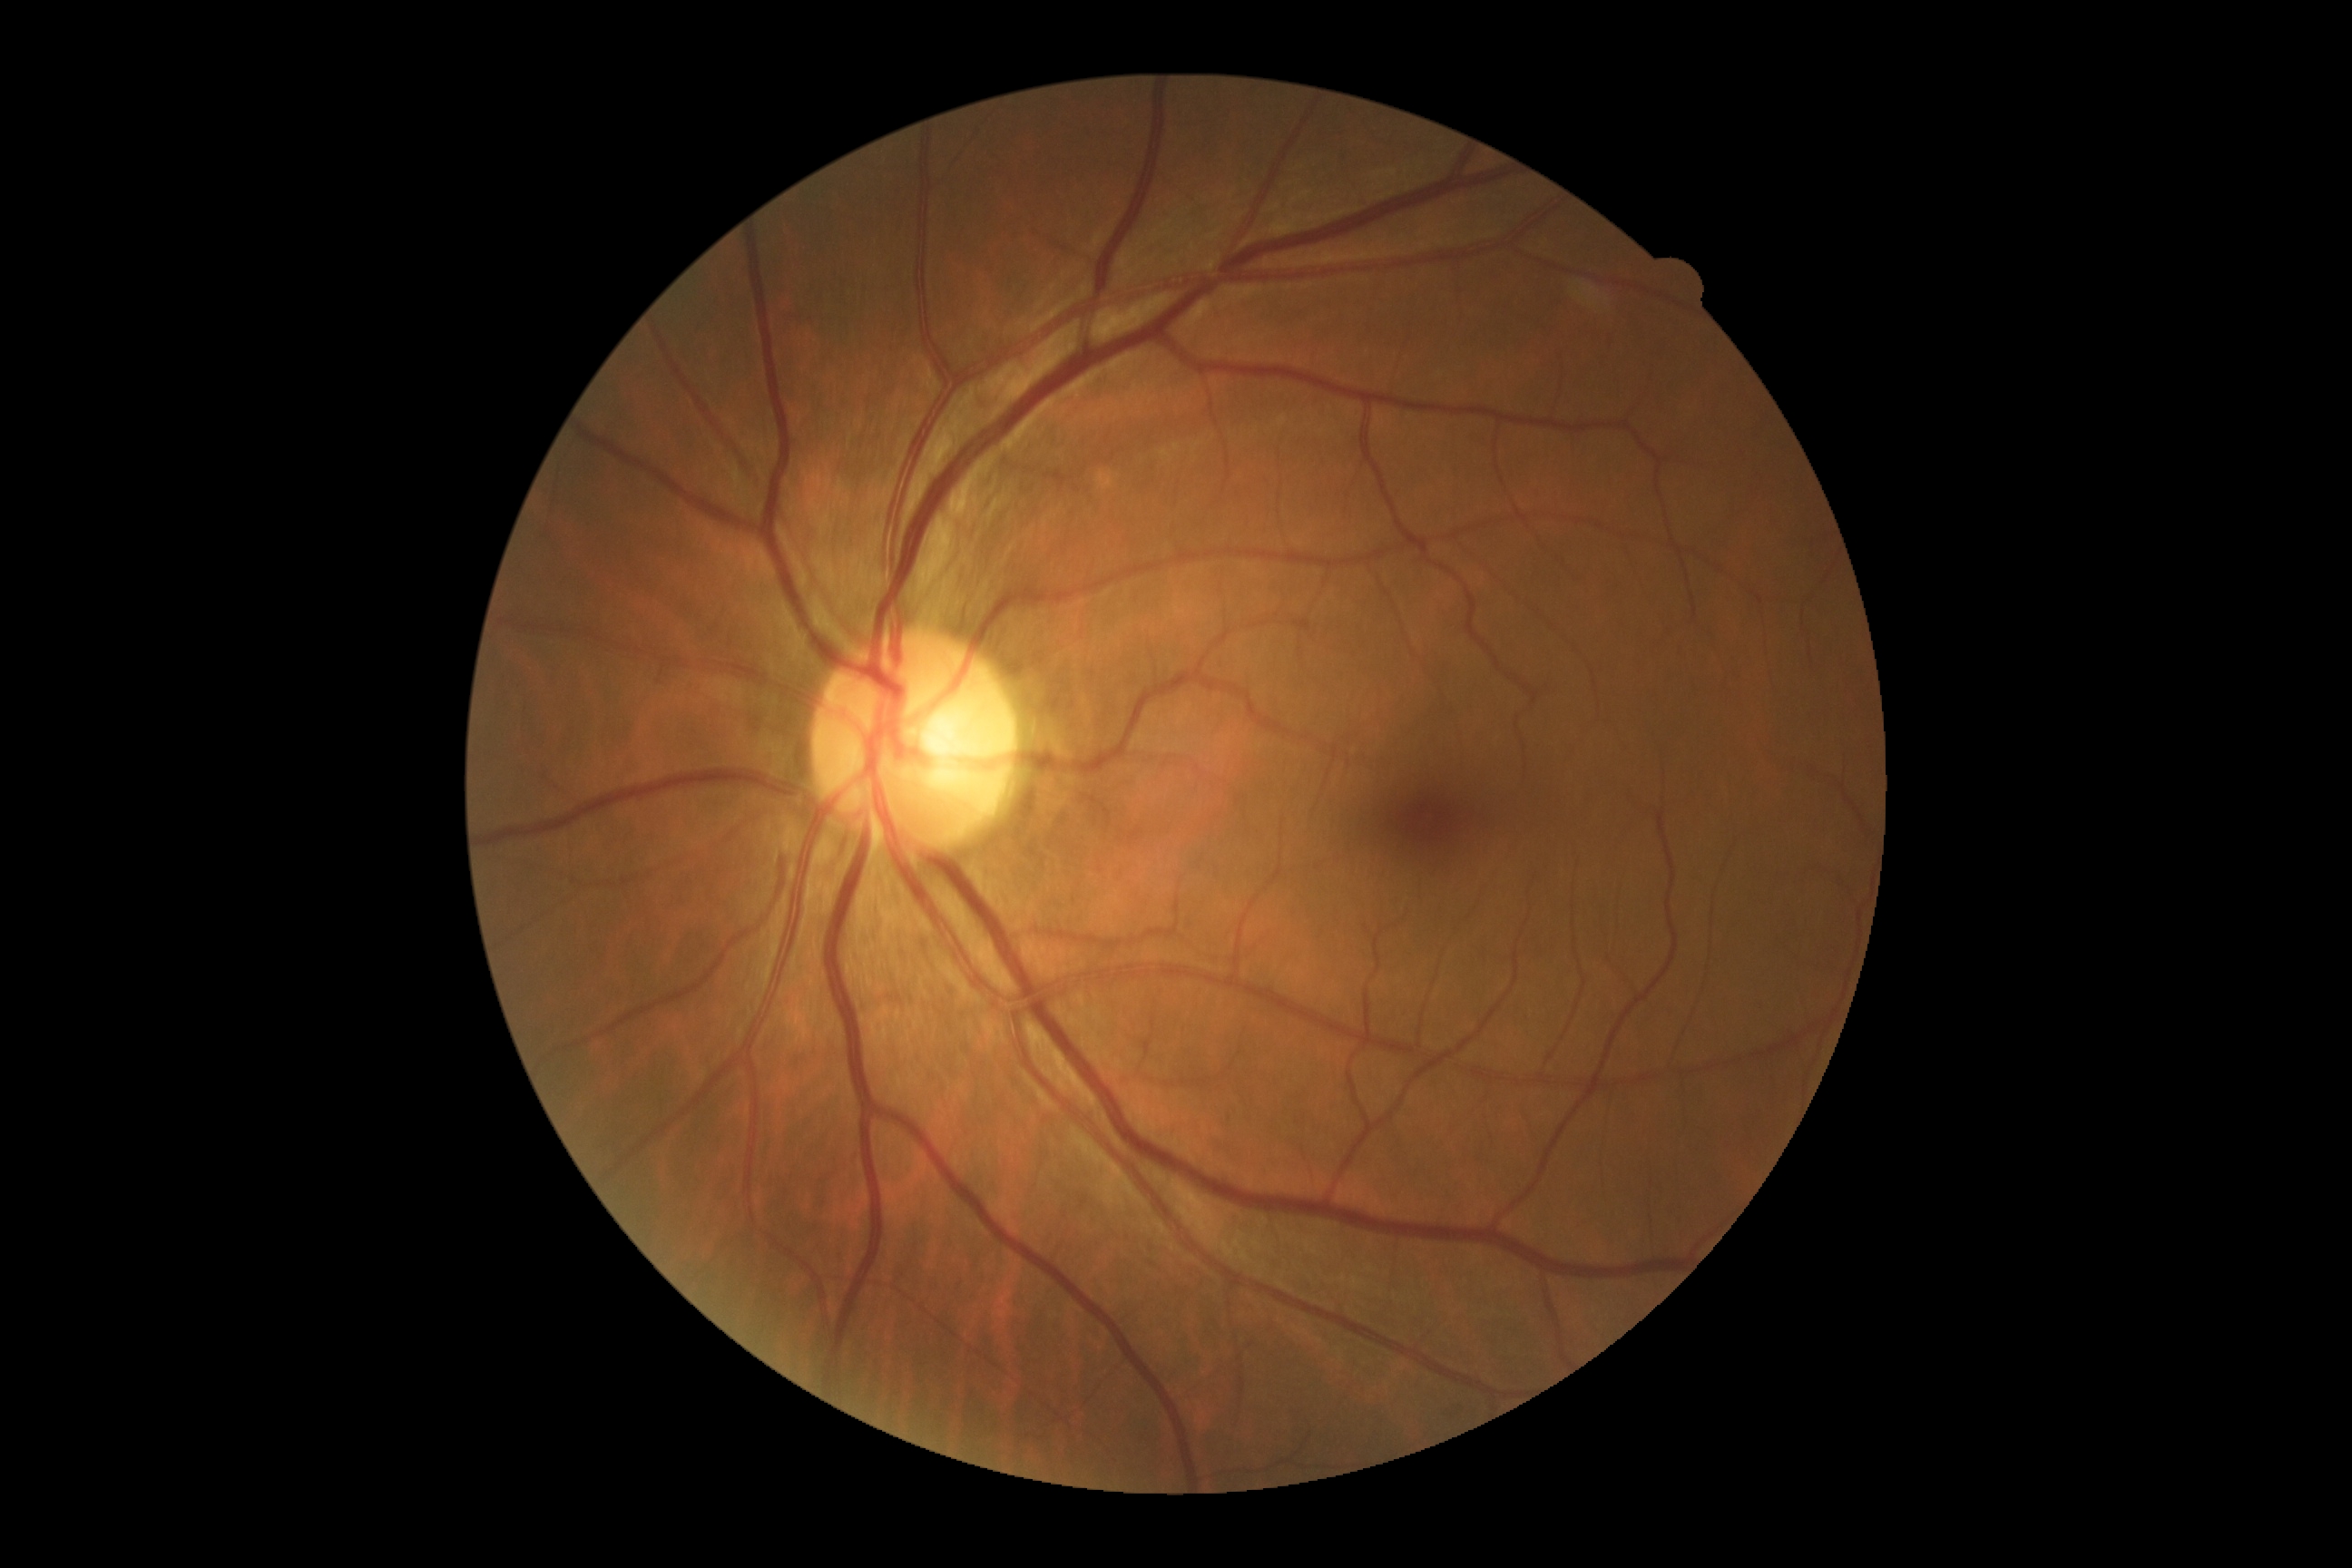
Findings:
– DR impression: negative for DR
– diabetic retinopathy: 0/4